Pediatric retinal photograph (wide-field):
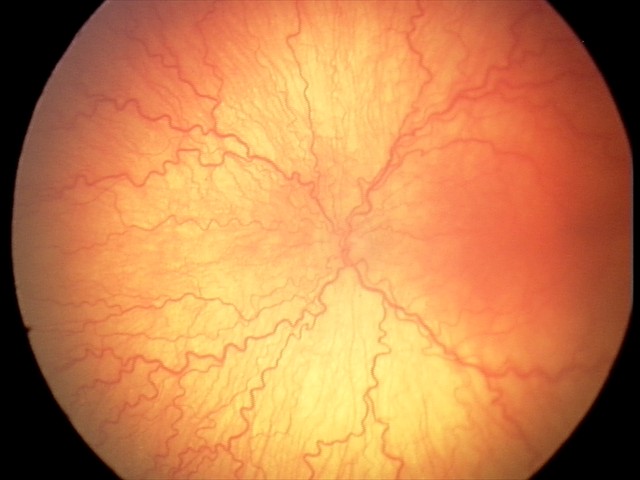
Series diagnosed as aggressive ROP (A-ROP).
Plus disease present.